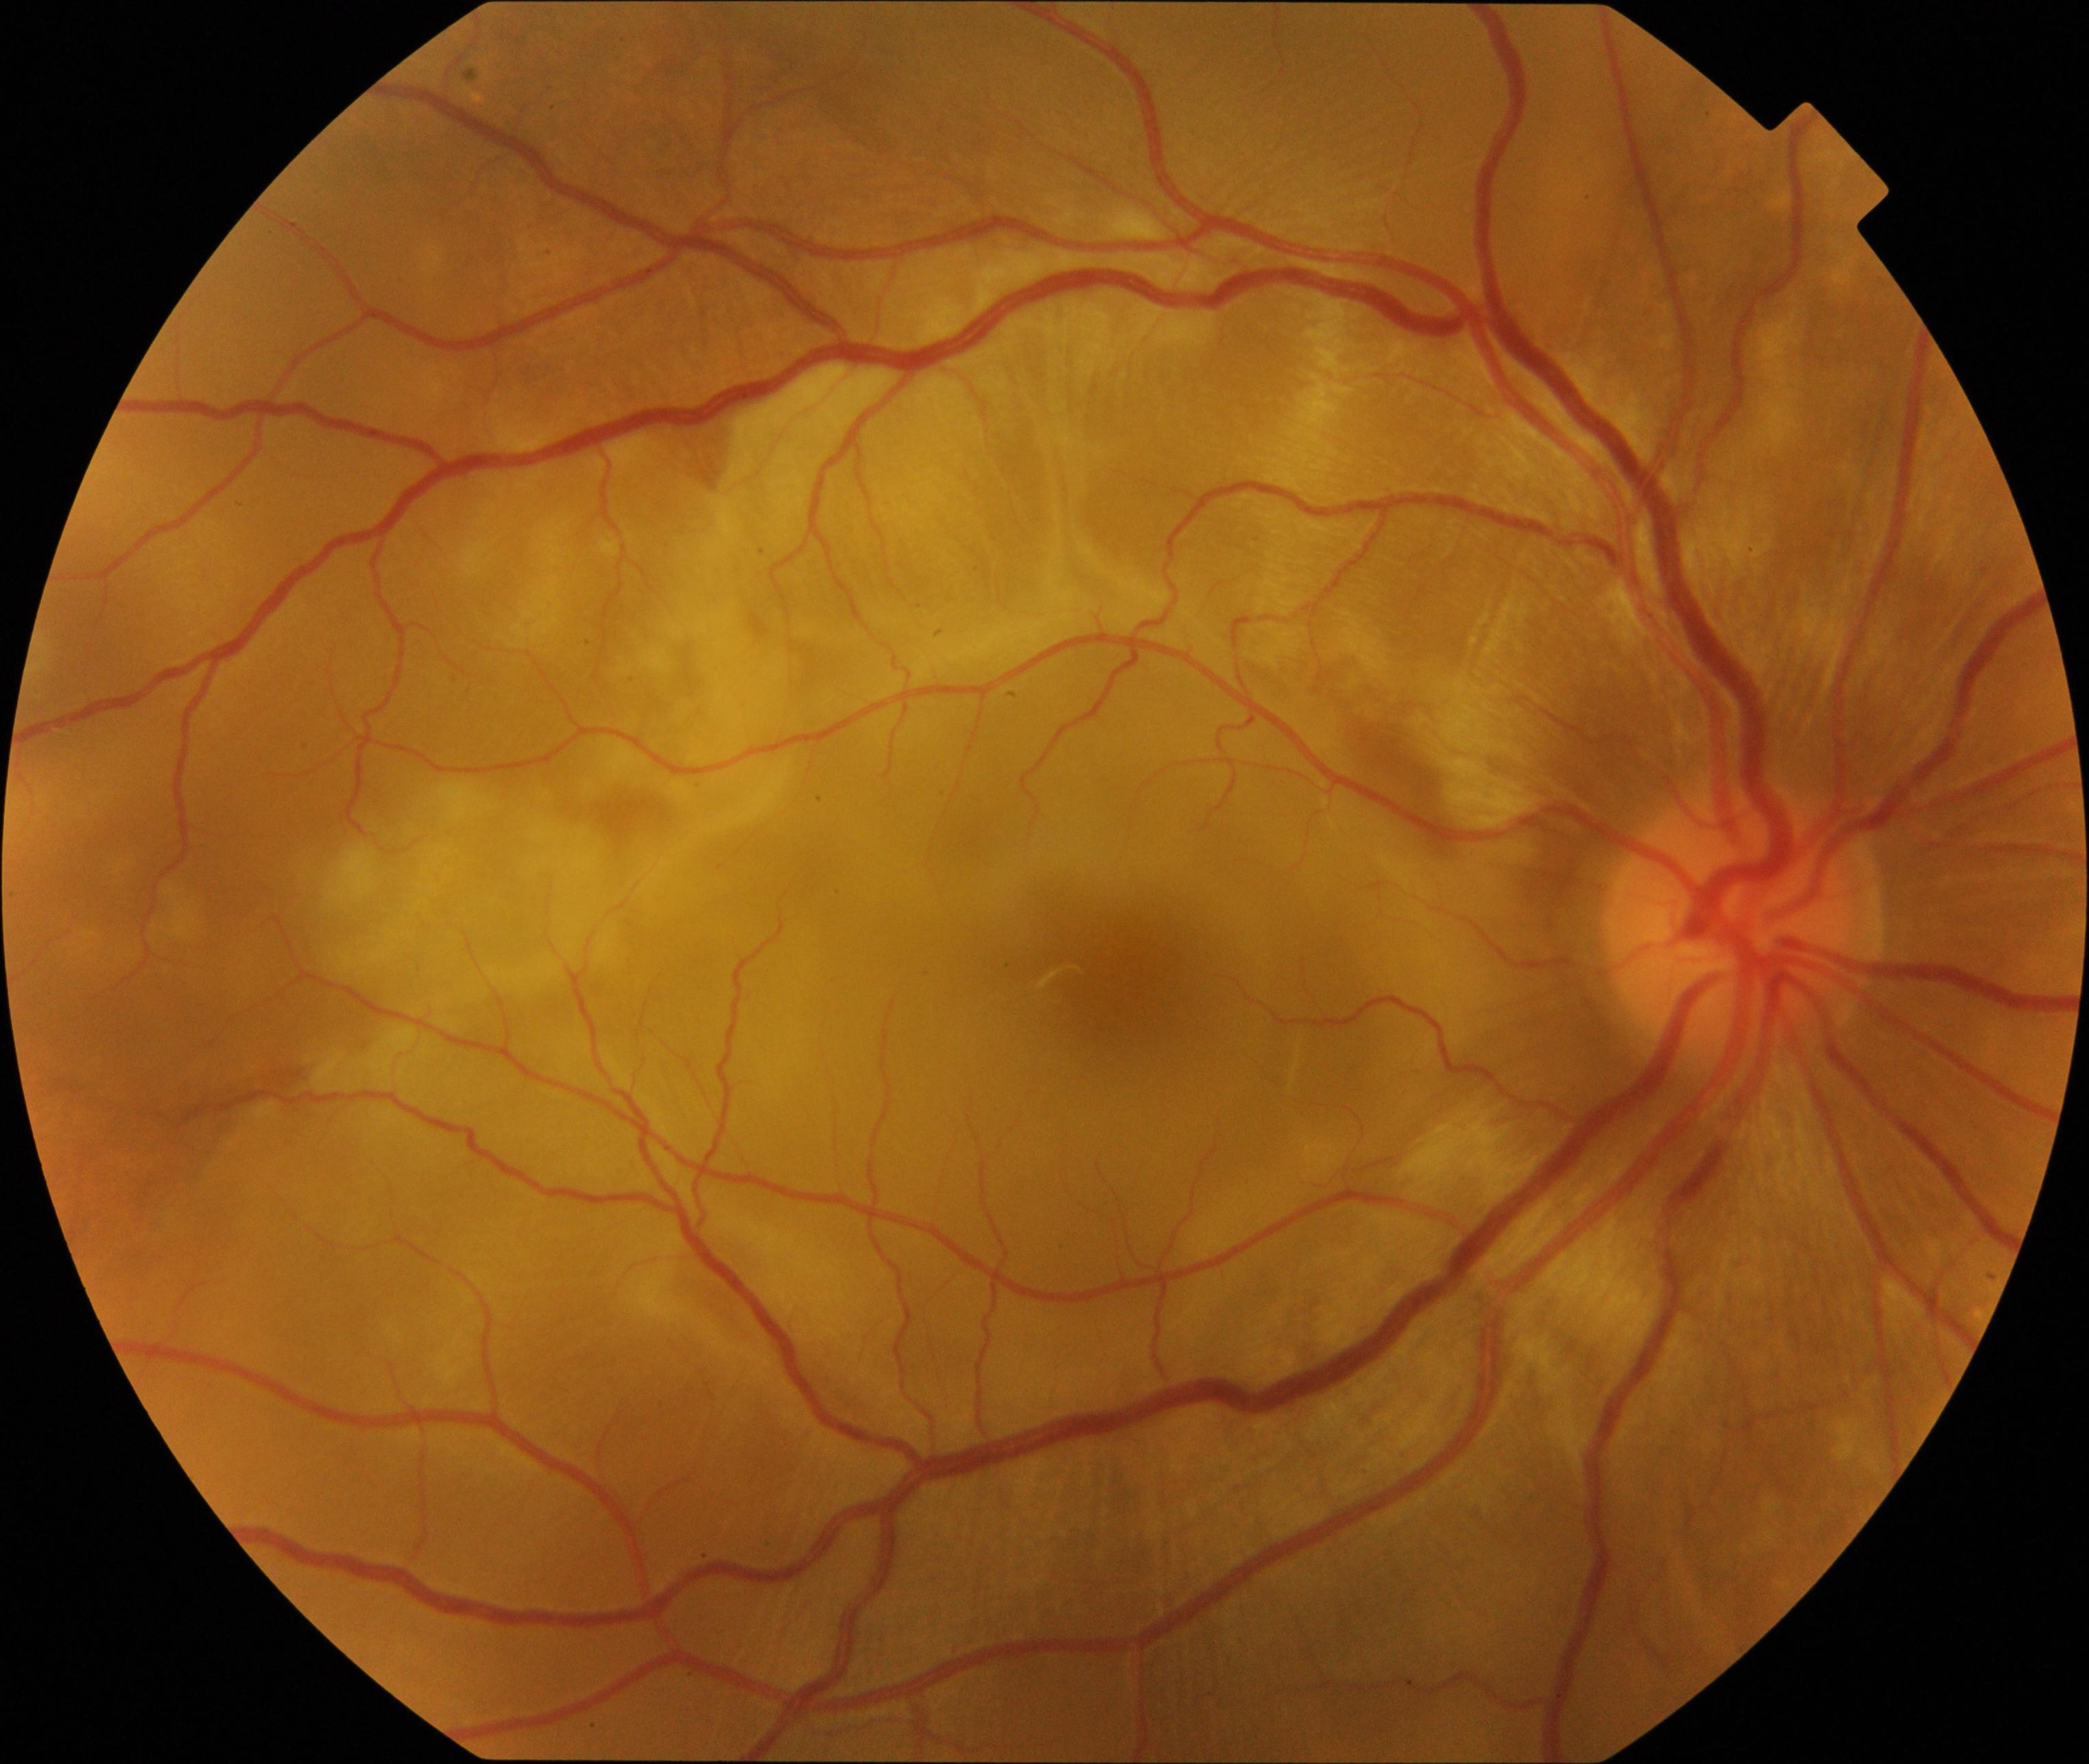 Impression: Vogt-Koyanagi-Harada disease.